Diabetic retinopathy graded by the modified Davis classification; nonmydriatic fundus photograph — 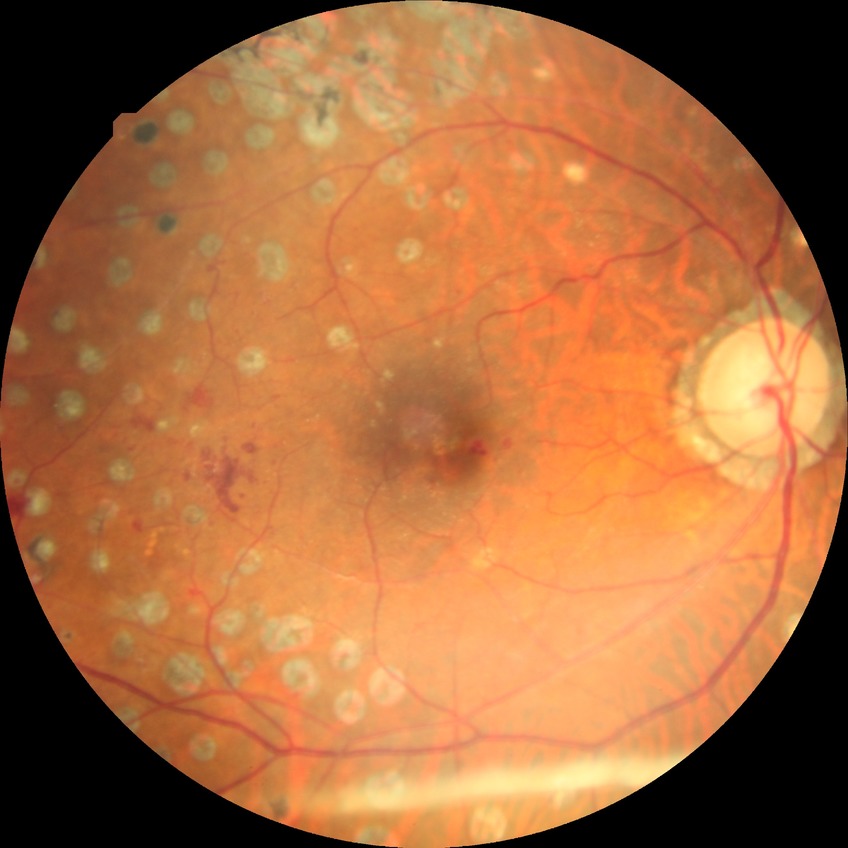

Modified Davis grading is proliferative diabetic retinopathy.